Captured with the Phoenix ICON (100° field of view). Phoenix ICON wide-field infant fundus image.
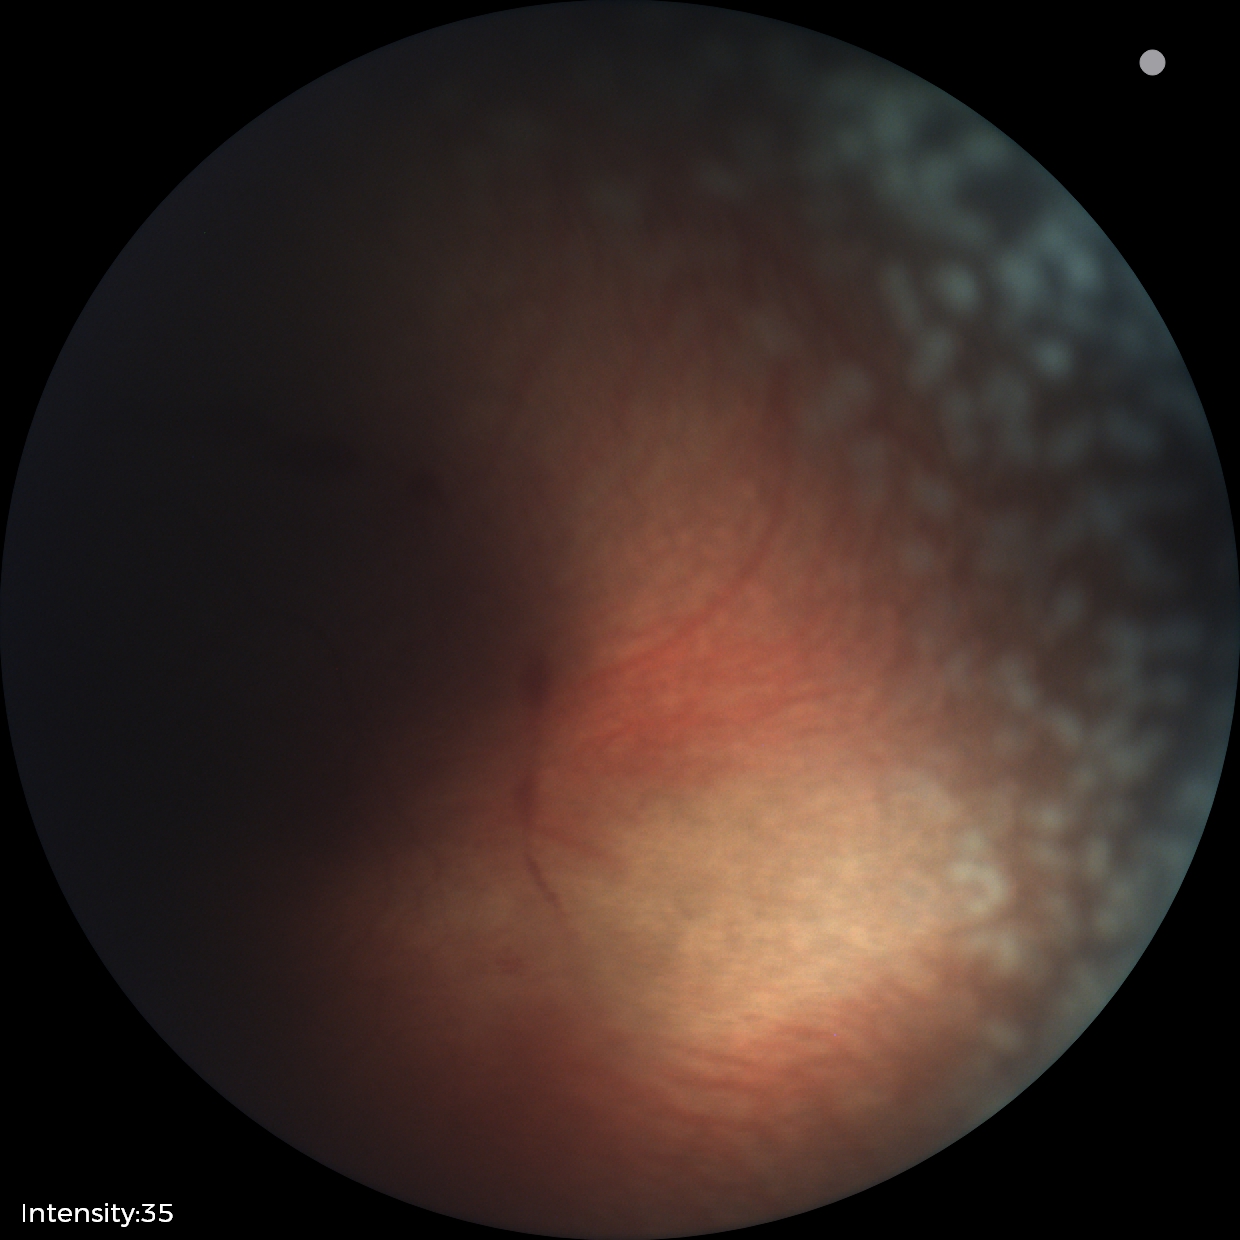
Q: What is the plus-form classification?
A: plus disease
Q: What is the diagnosis from this examination?
A: retinopathy of prematurity (ROP) stage 2